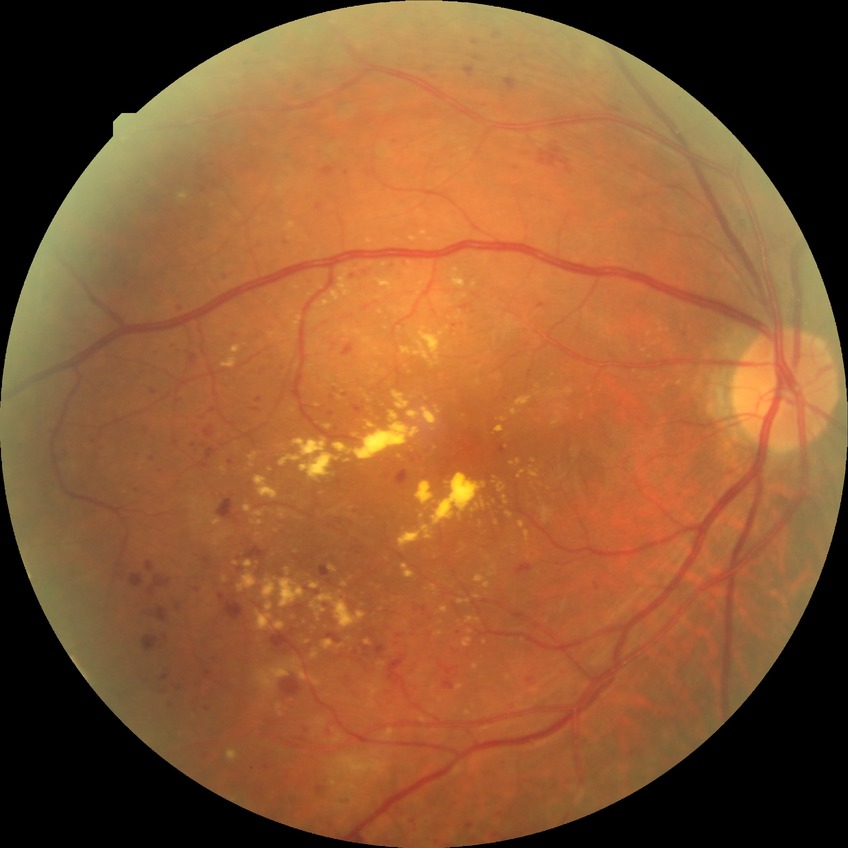
DR grade is PDR.